CFP; FOV: 45 degrees; 1932x1916: 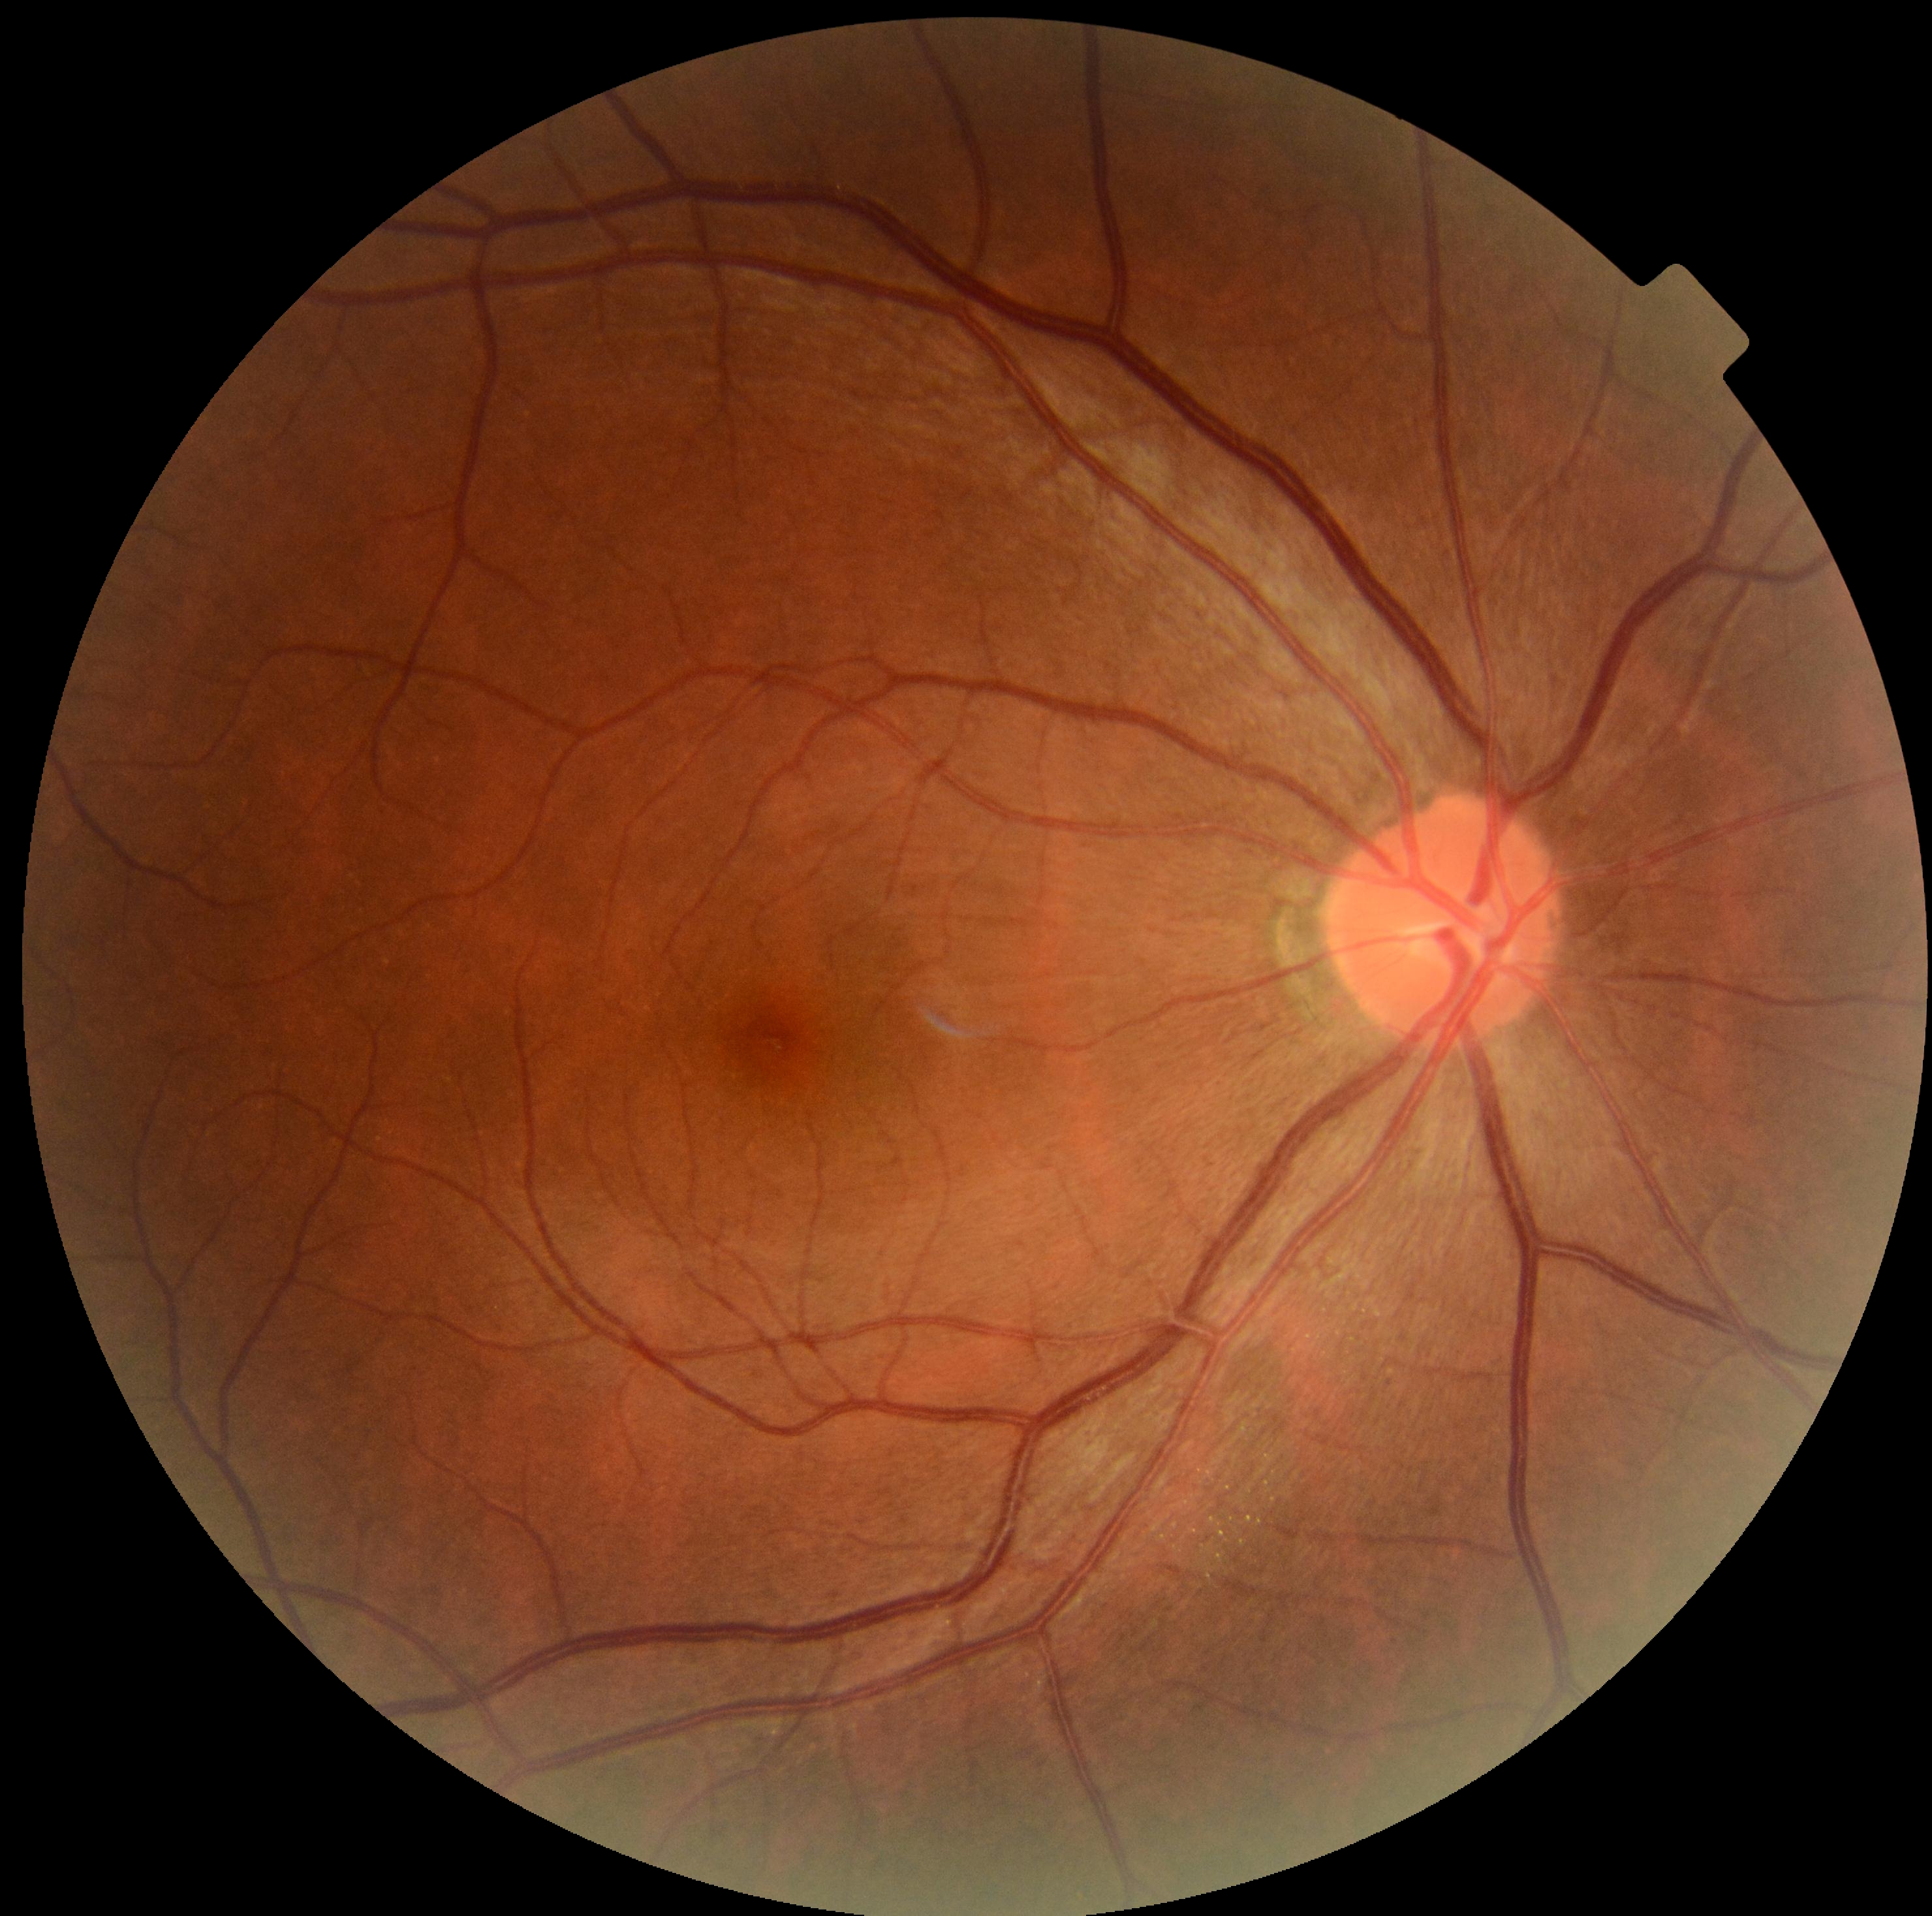 Retinopathy: grade 0.